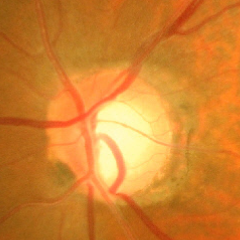

Q: Does this eye have glaucoma?
A: Advanced glaucoma.